Fundus photograph cropped around the optic nerve head
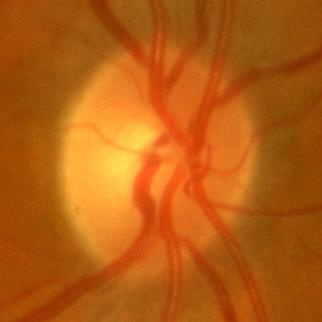

Q: Does this eye have glaucoma?
A: No — no signs of glaucoma.